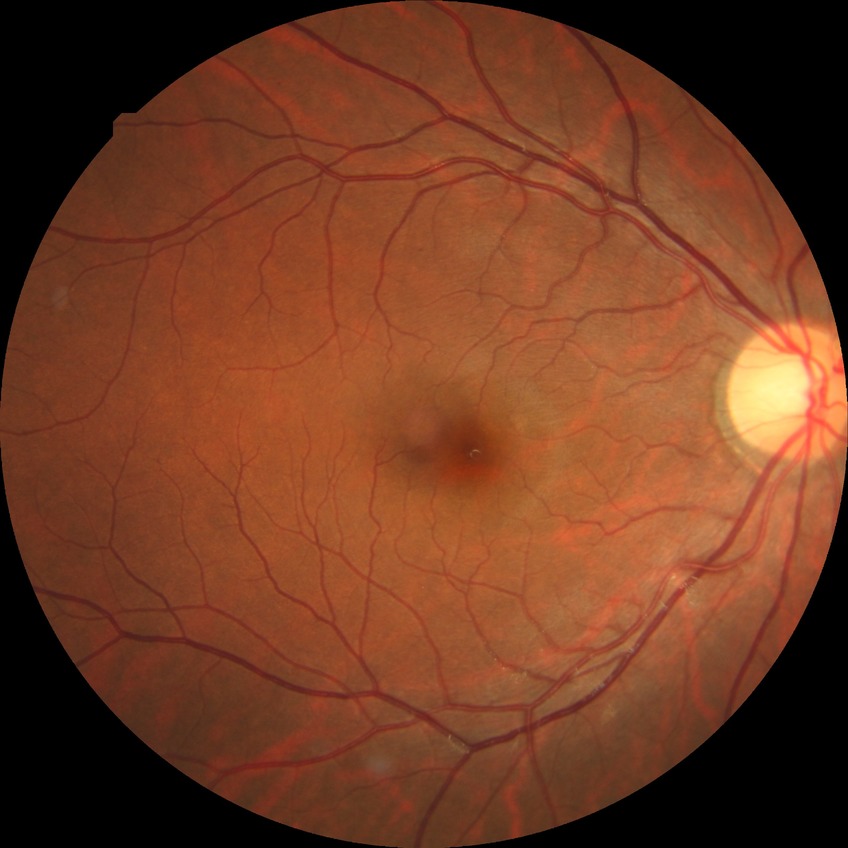
Disease class: non-proliferative diabetic retinopathy. Diabetic retinopathy (DR) is simple diabetic retinopathy (SDR).